848x848px · FOV: 45 degrees
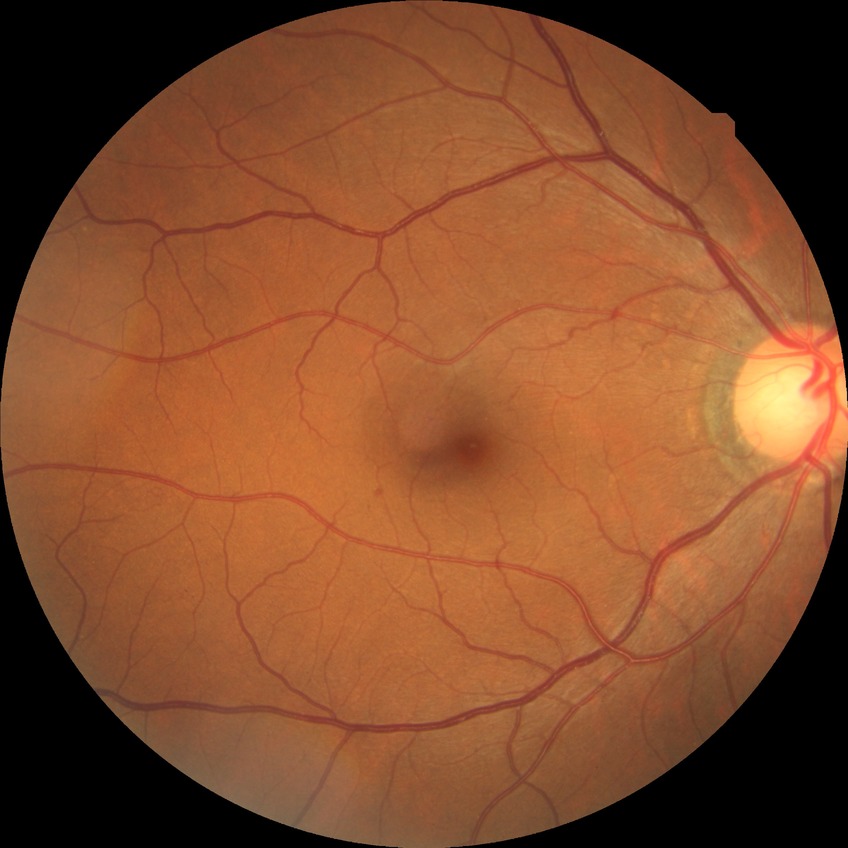
Diabetic retinopathy (DR) is NDR (no diabetic retinopathy).